2352 x 1568 pixels:
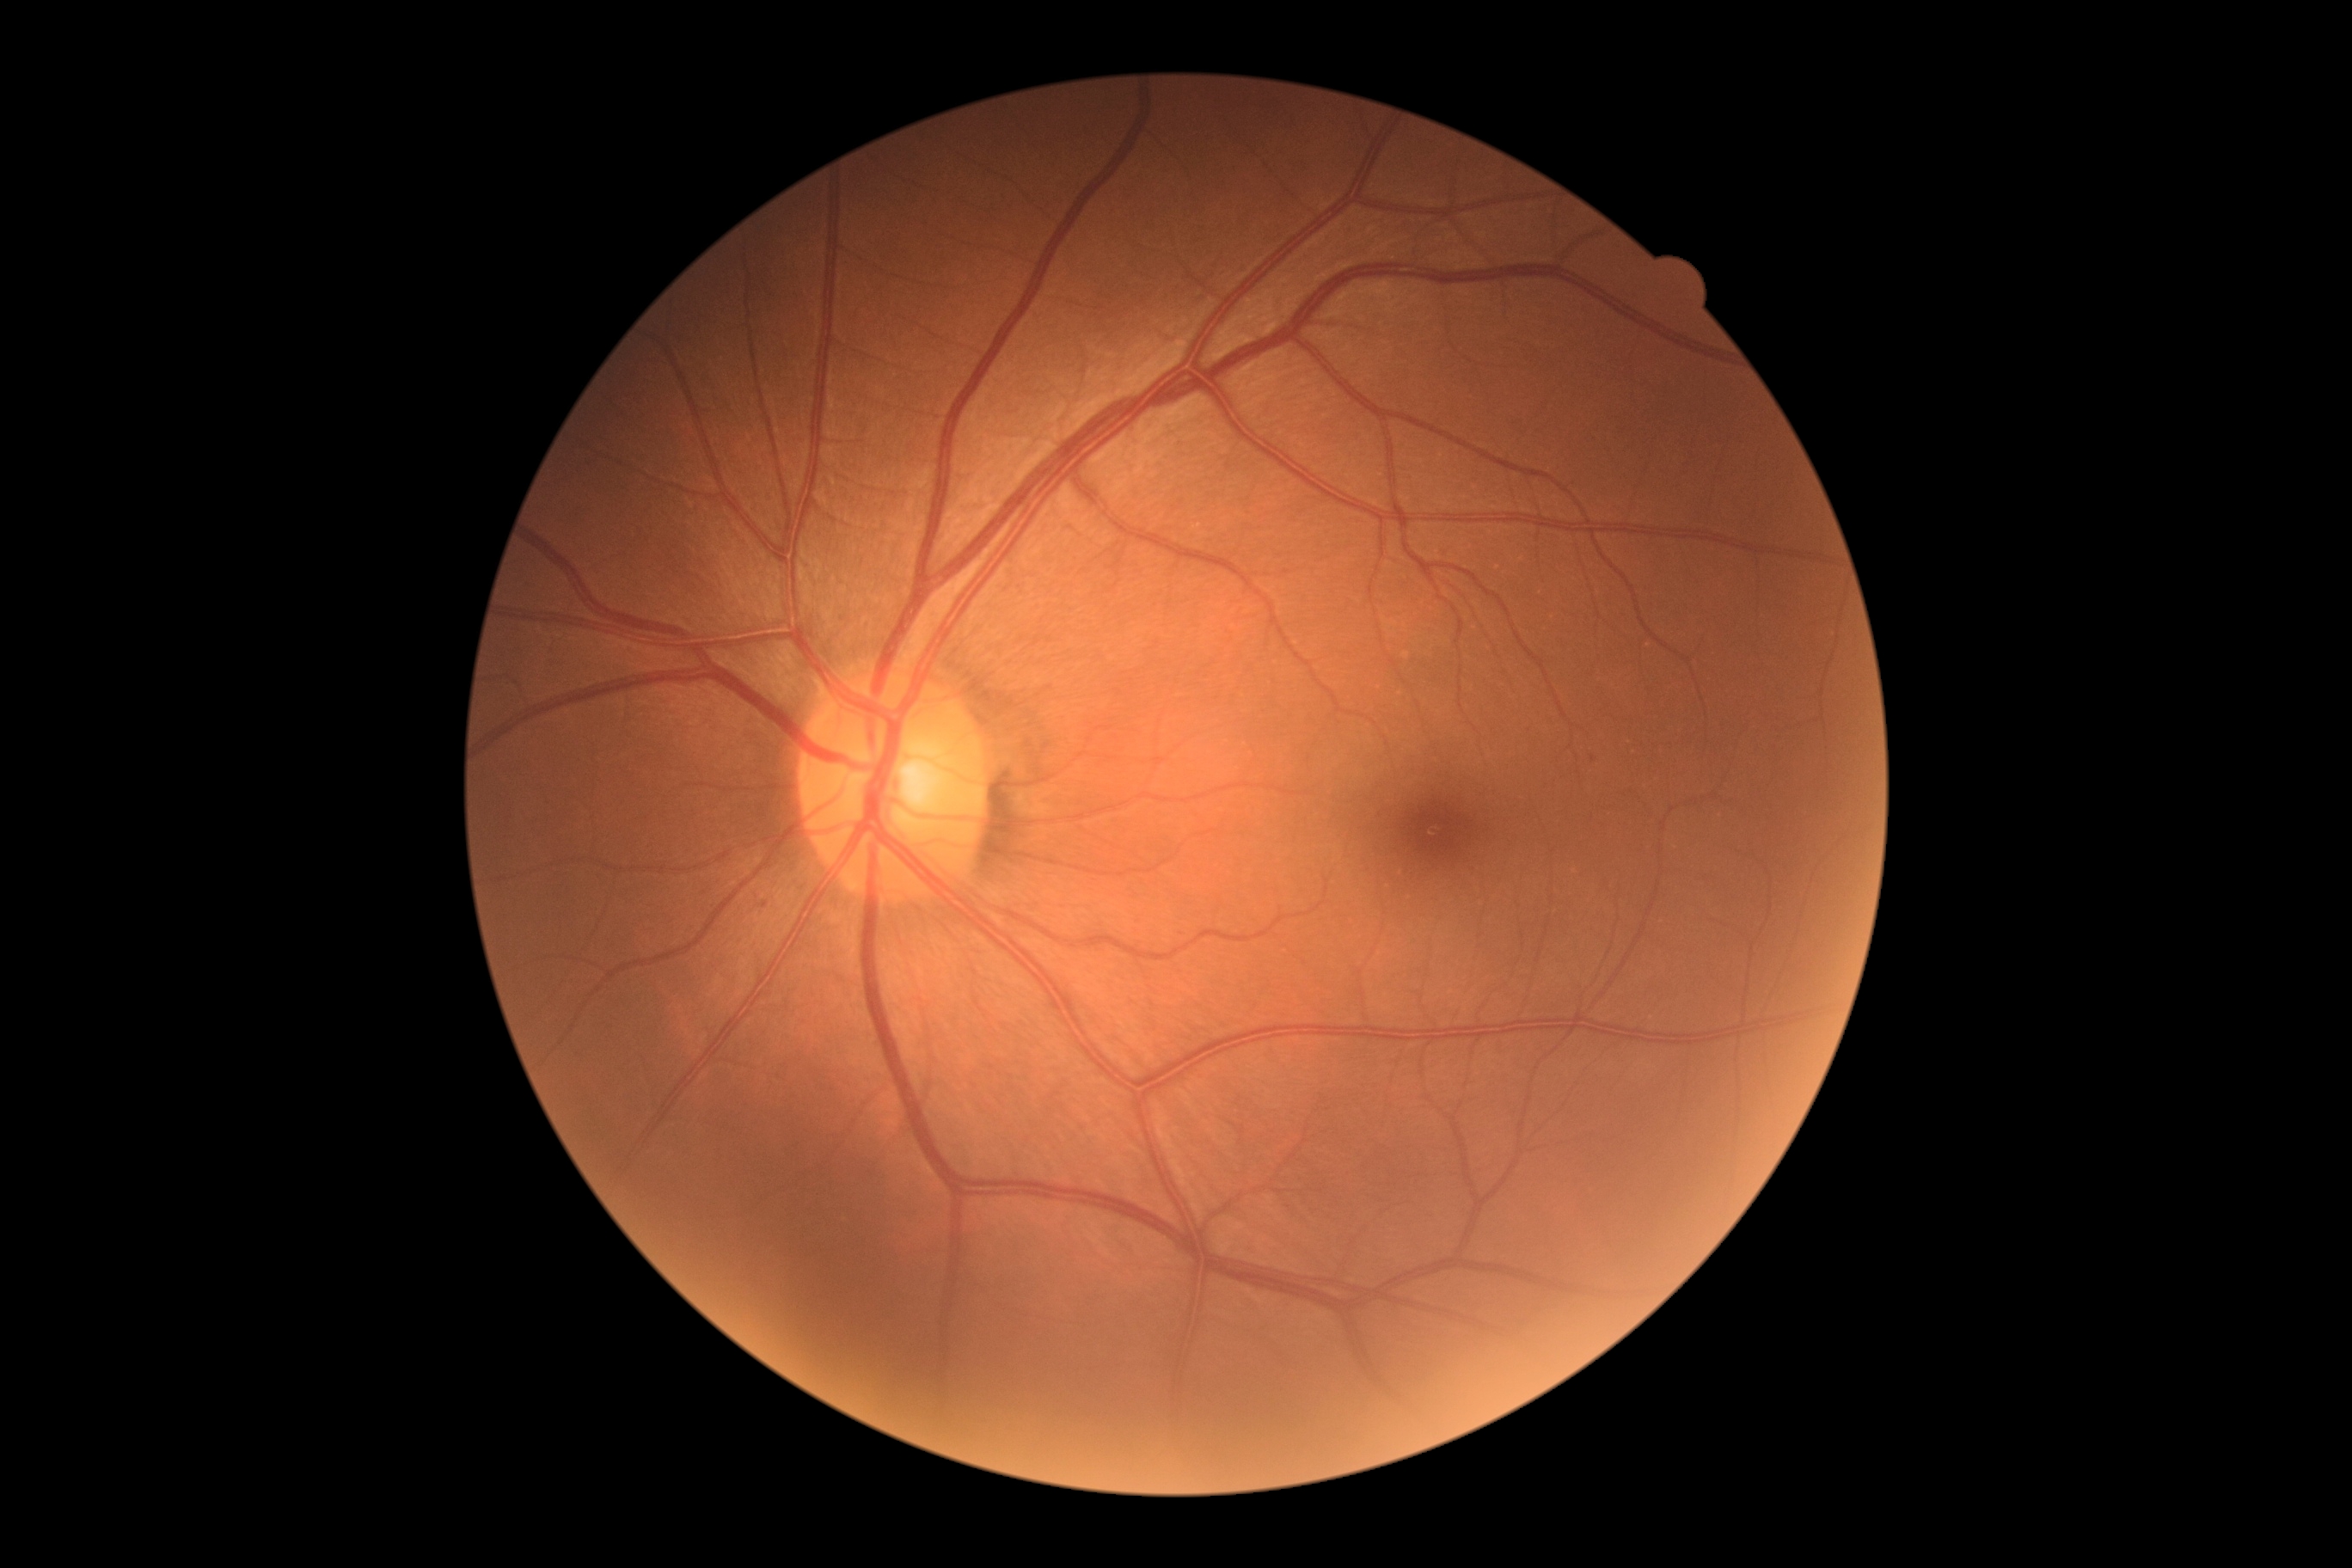

{"dr_category": "non-proliferative diabetic retinopathy", "dr_grade": "mild non-proliferative diabetic retinopathy (grade 1)"}